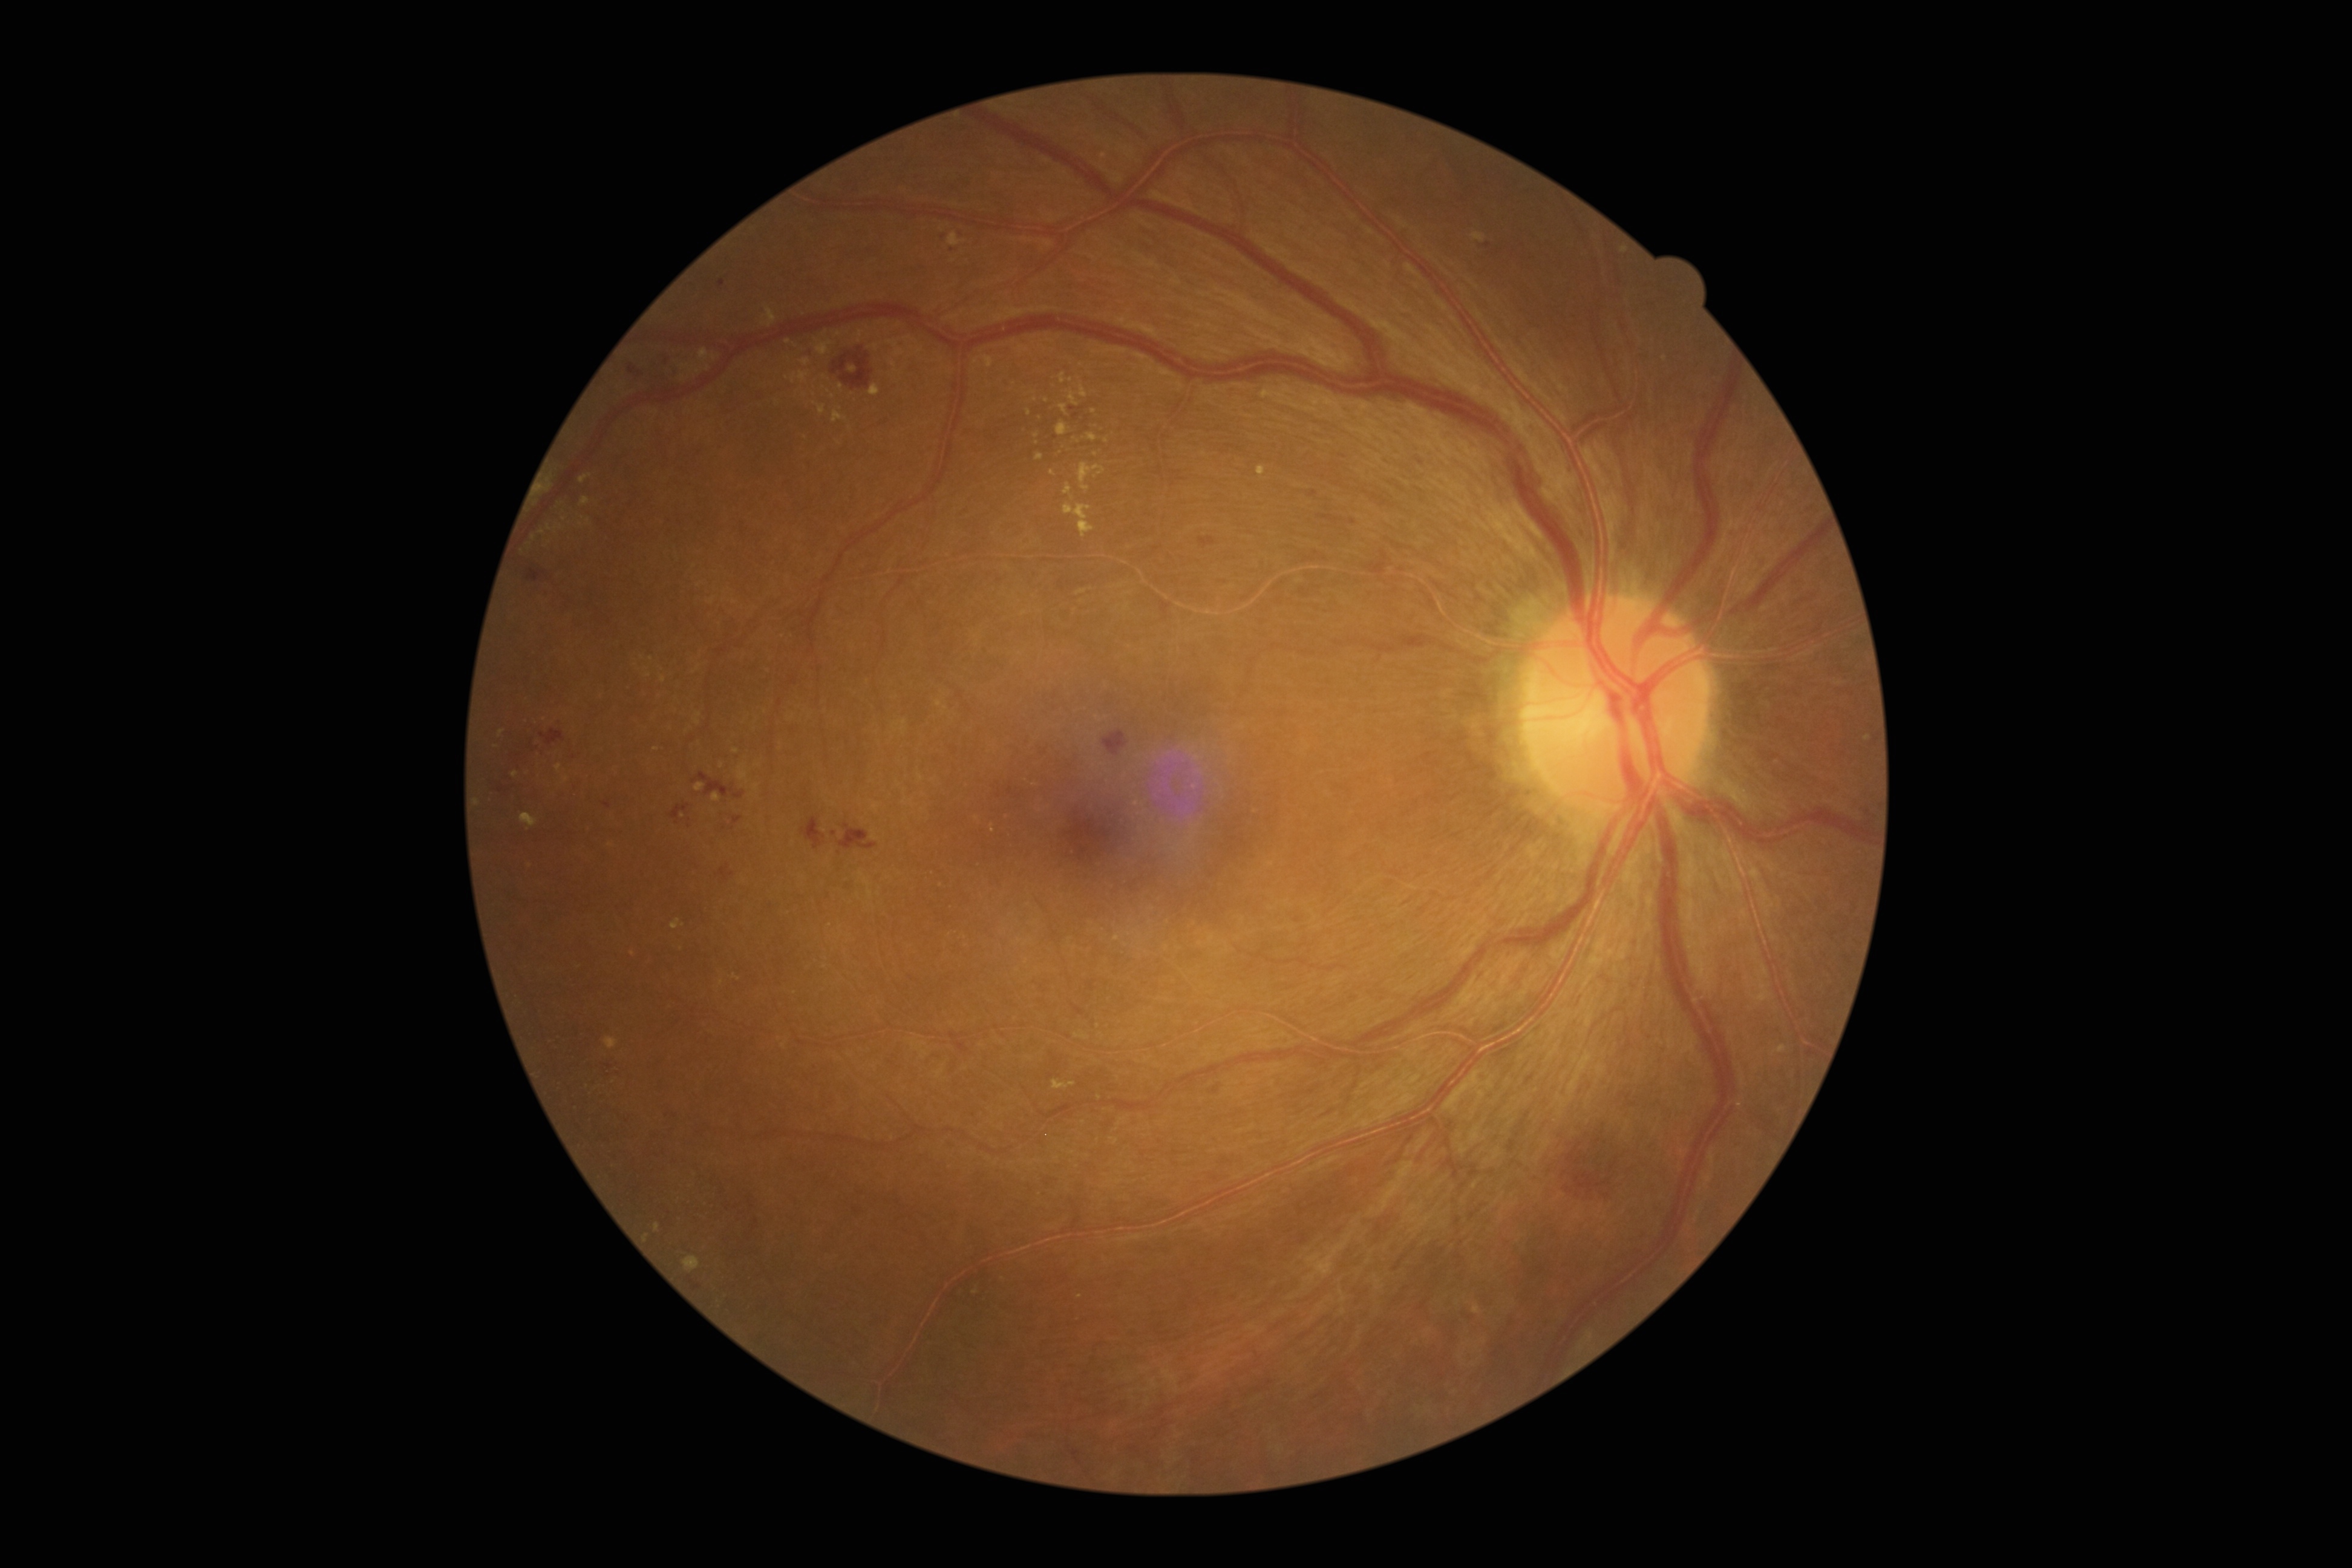

partial: true
dr_grade: 2
lesions:
  ex:
    - [1087, 434, 1097, 442]
    - [869, 385, 880, 396]
    - [1079, 463, 1105, 492]
    - [1080, 385, 1087, 399]
    - [1036, 453, 1045, 462]
    - [1069, 390, 1079, 407]
    - [1052, 1081, 1076, 1091]
    - [512, 771, 520, 779]
    - [816, 341, 835, 356]
    - [890, 360, 902, 376]
  ex_small_approx:
    - (542,533)
    - (478,802)
    - (875,347)
    - (534,538)
    - (1037,435)
    - (1104,156)
    - (529,546)
    - (788,342)
    - (1071,380)